Image size 1920x1088.
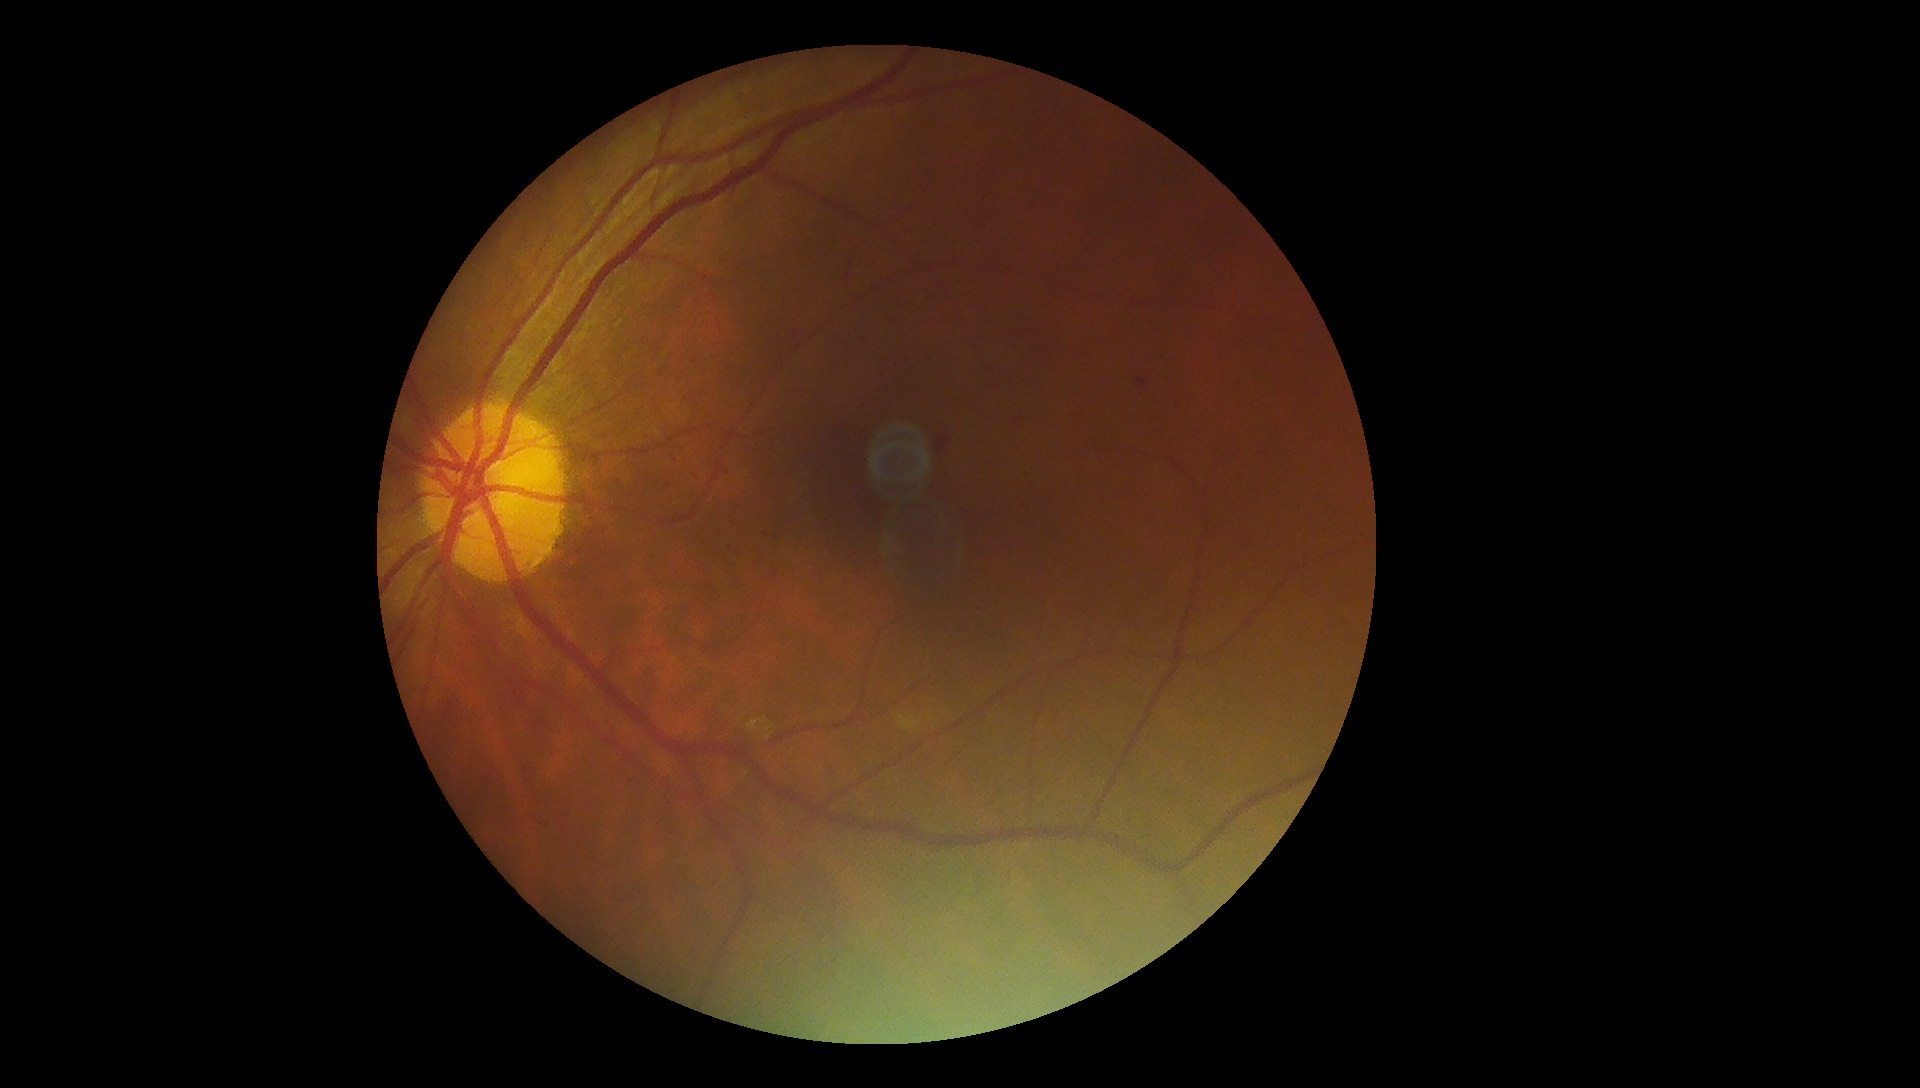

DR stage = grade 2.